Camera: NIDEK AFC-230; 848 by 848 pixels.
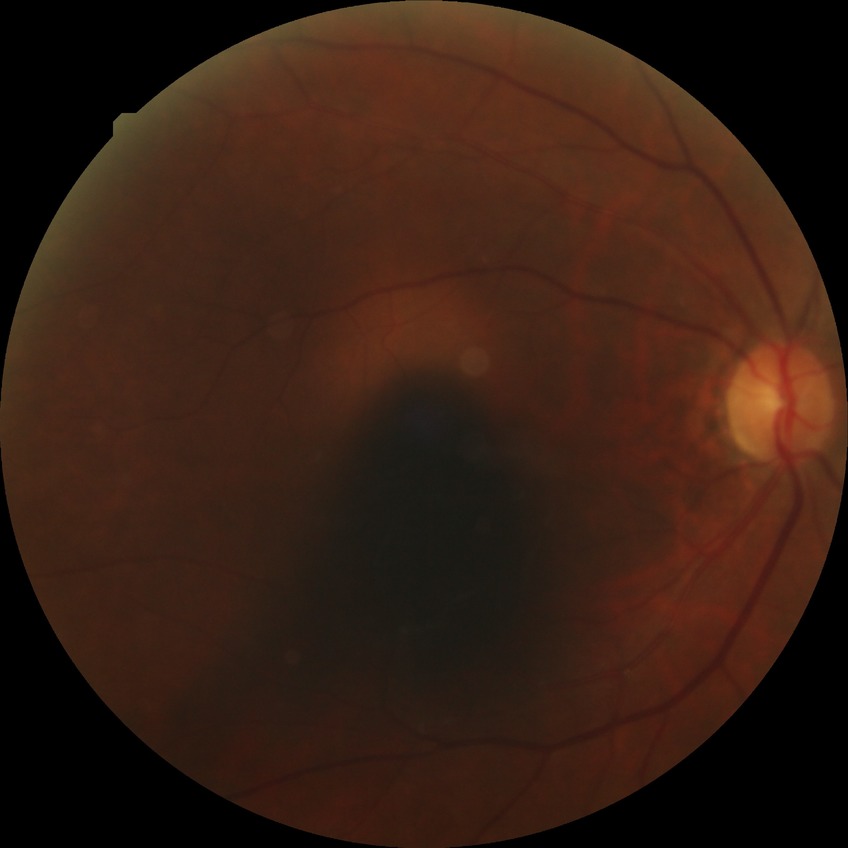 DR class@non-proliferative diabetic retinopathy, diabetic retinopathy (DR)@SDR (simple diabetic retinopathy).